CFP · 2048x1536:
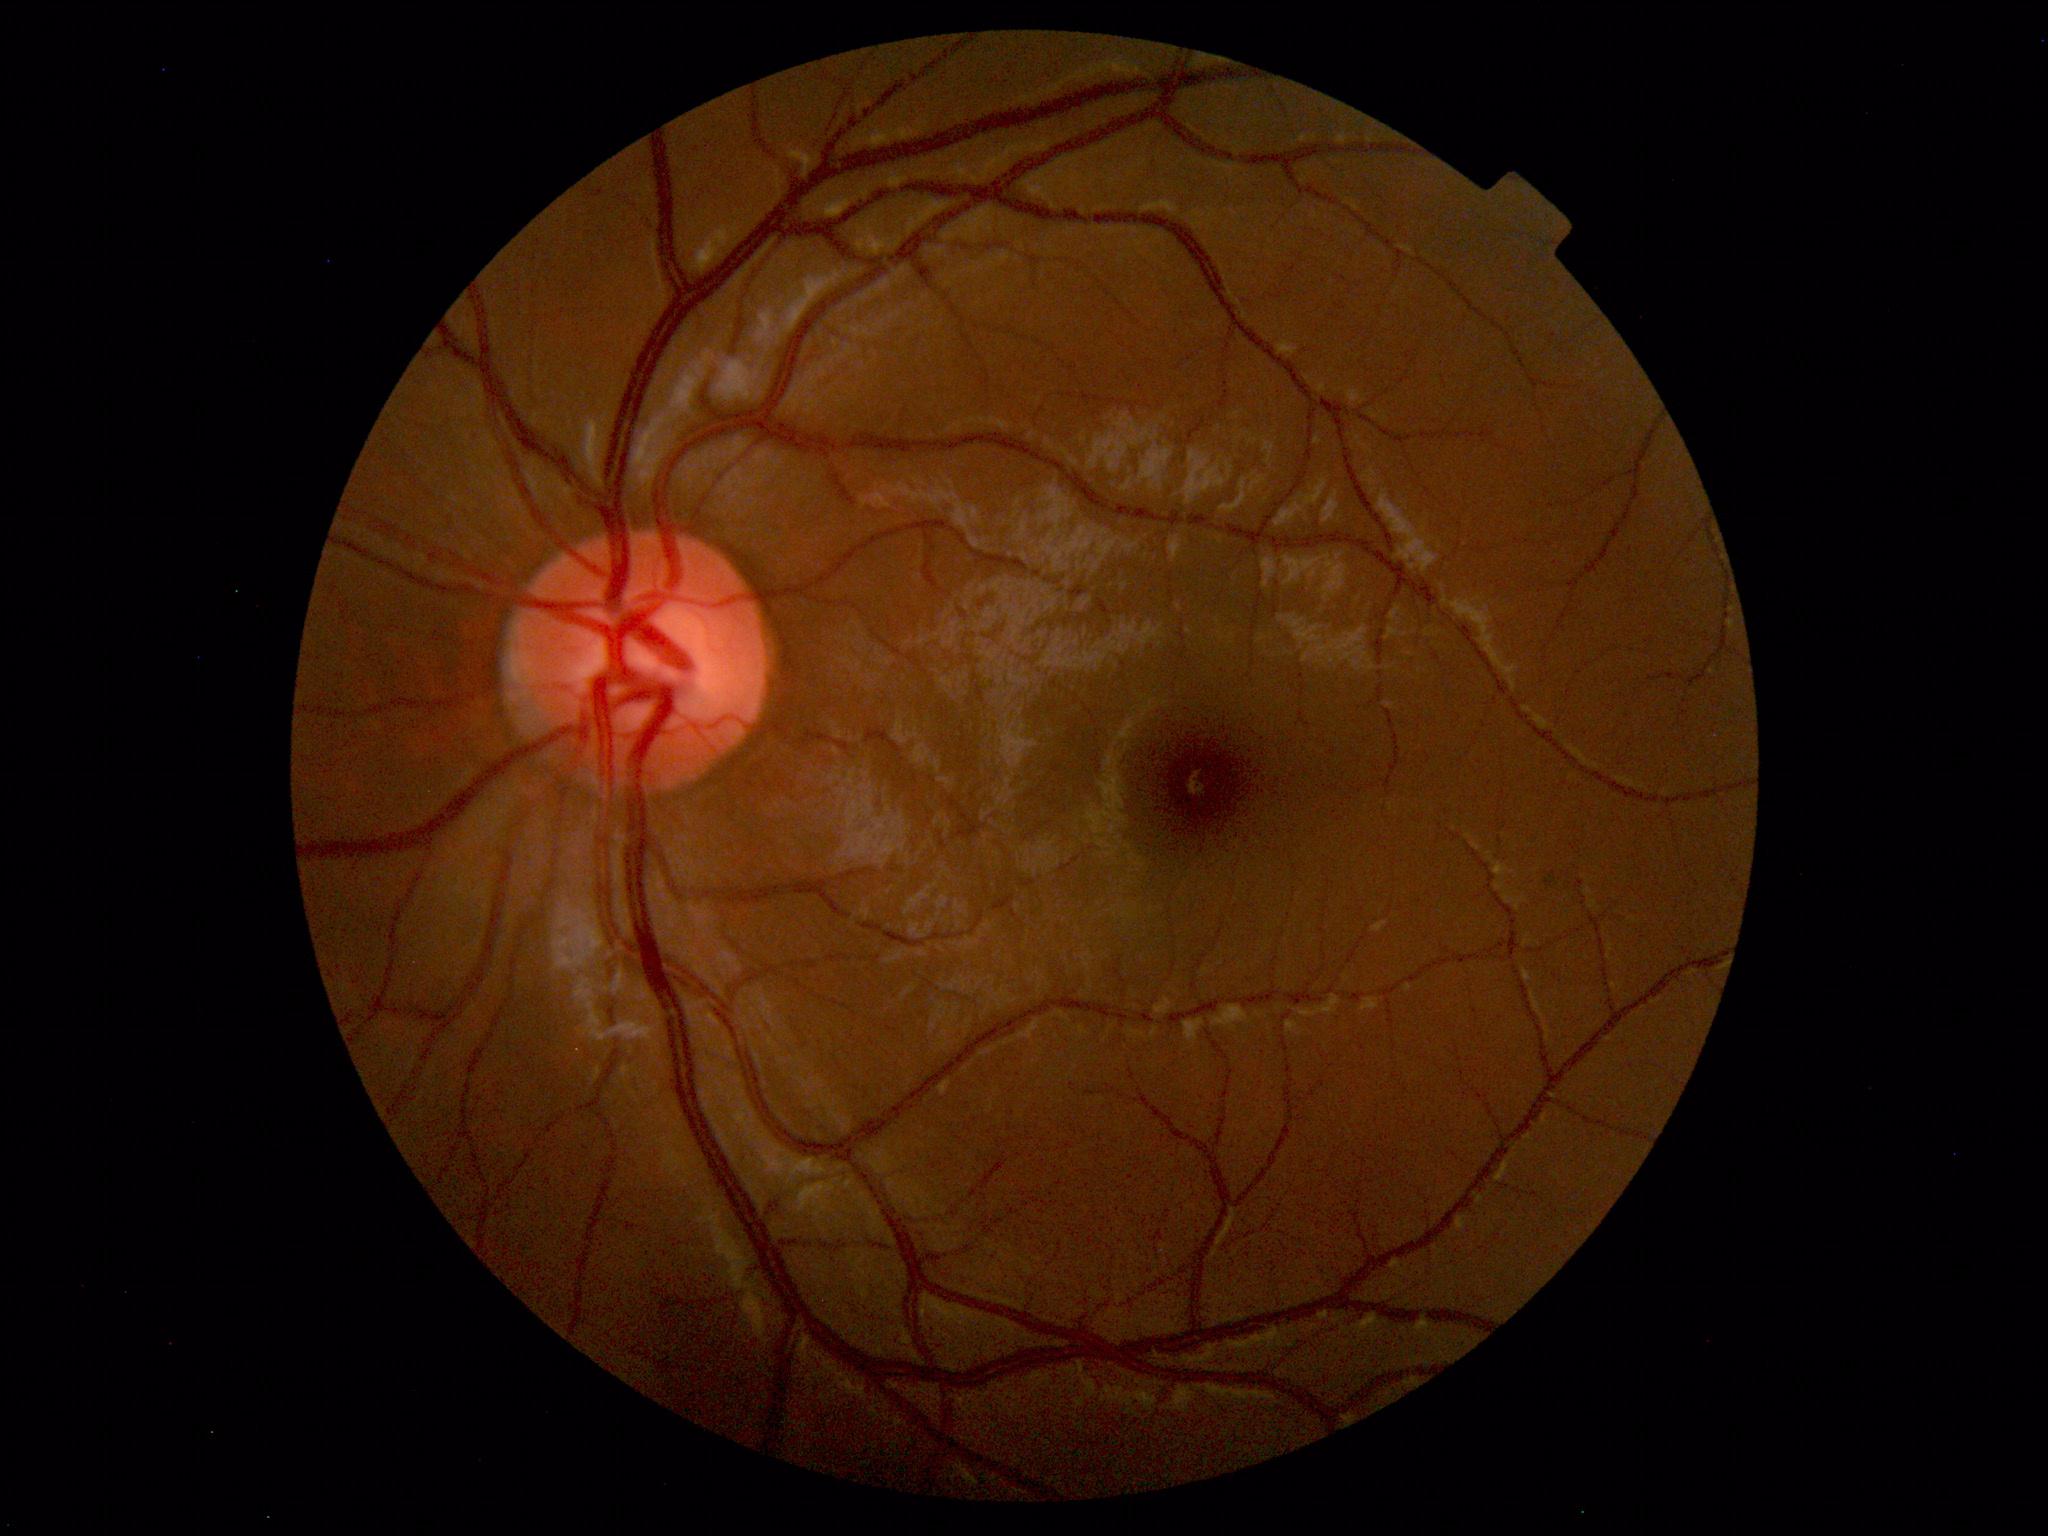
Normal fundus. No pathology identified.